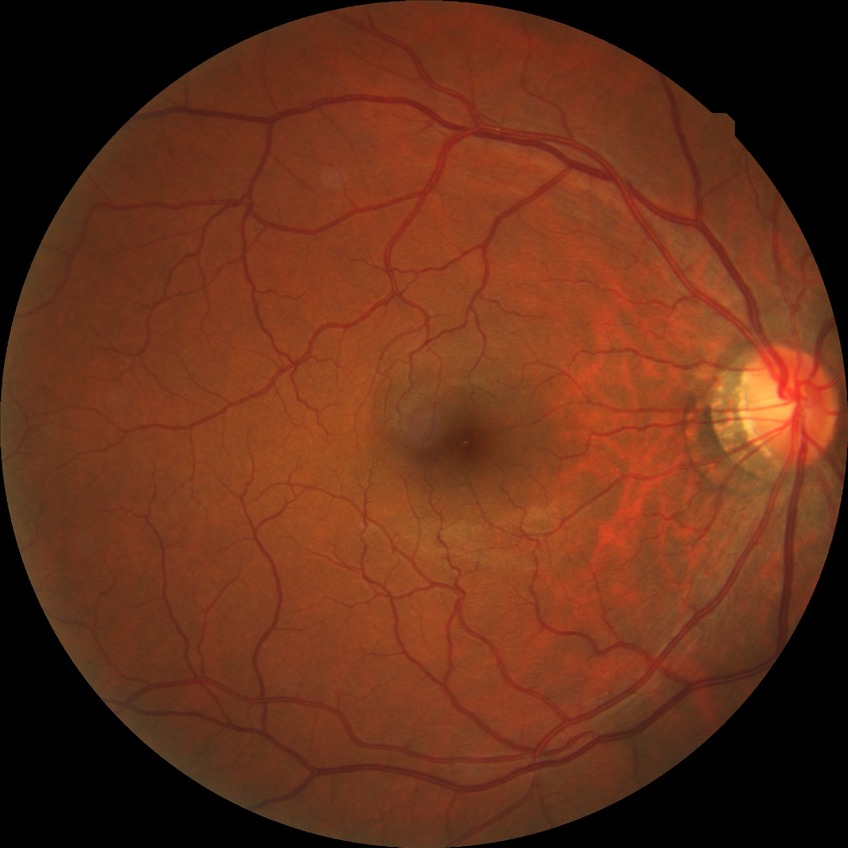
Diabetic retinopathy grade is no diabetic retinopathy.